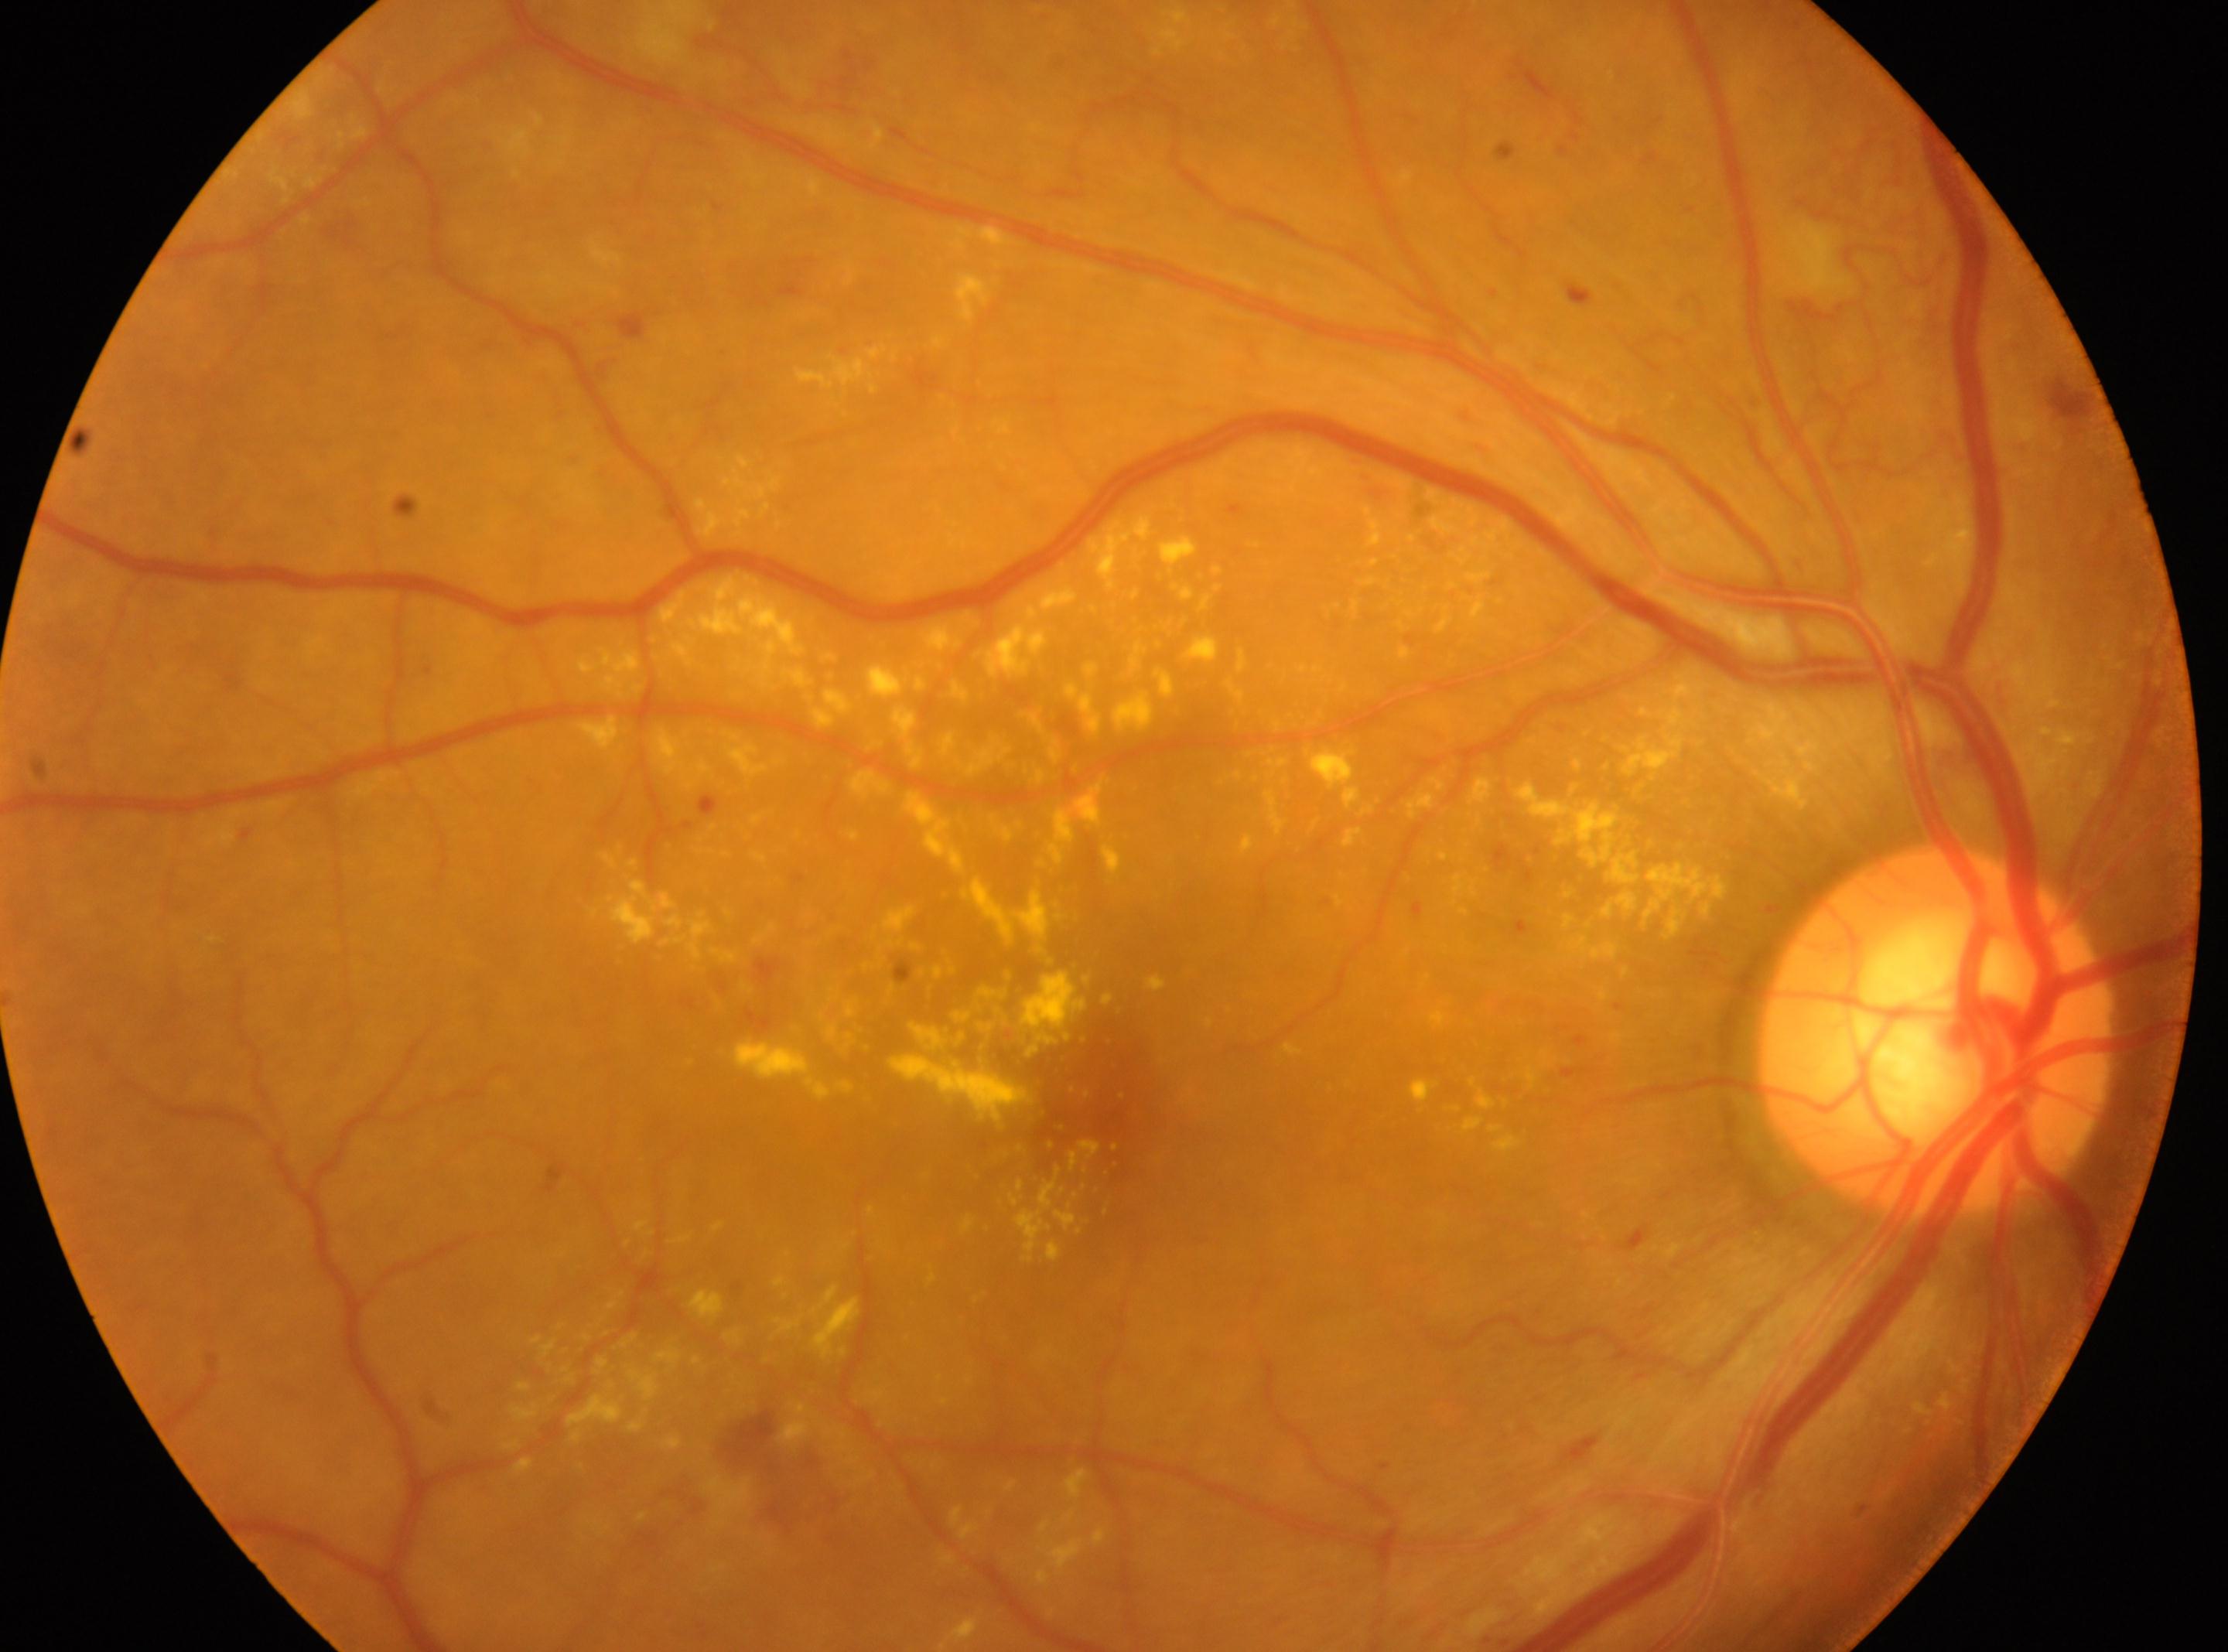

{
  "fovea": "x=1100, y=1098",
  "eye": "right",
  "dr_grade": "4 (PDR) — neovascularization and/or vitreous/pre-retinal hemorrhage",
  "optic_disc": "x=1935, y=1031"
}